45 degree fundus photograph; modified Davis grading — 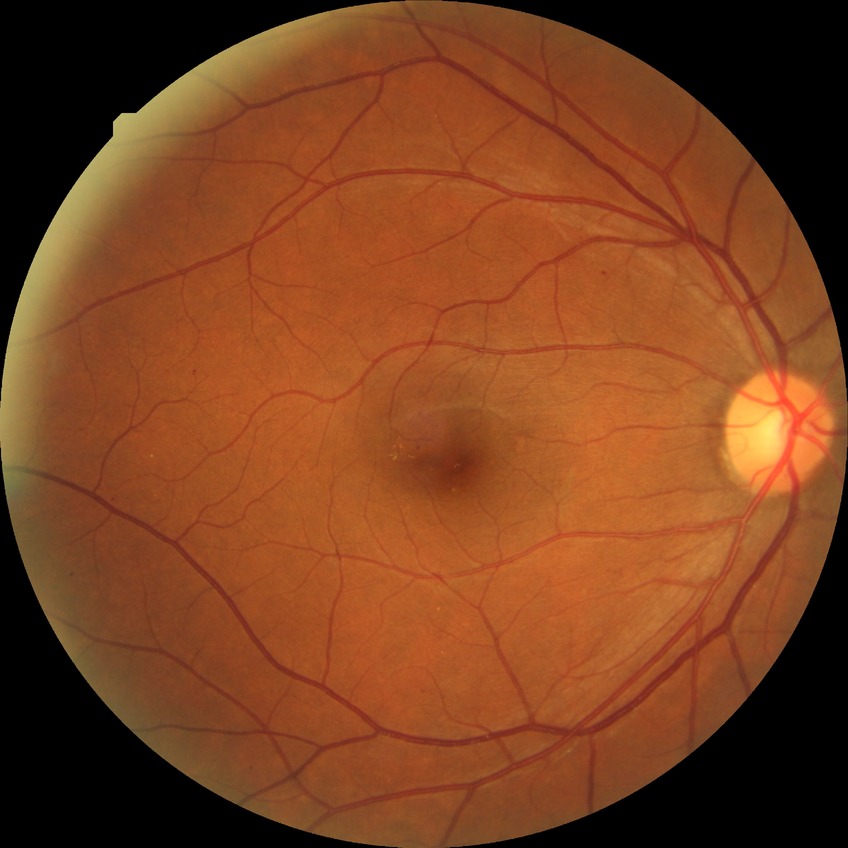

DR: SDR.
Disease class: non-proliferative diabetic retinopathy.